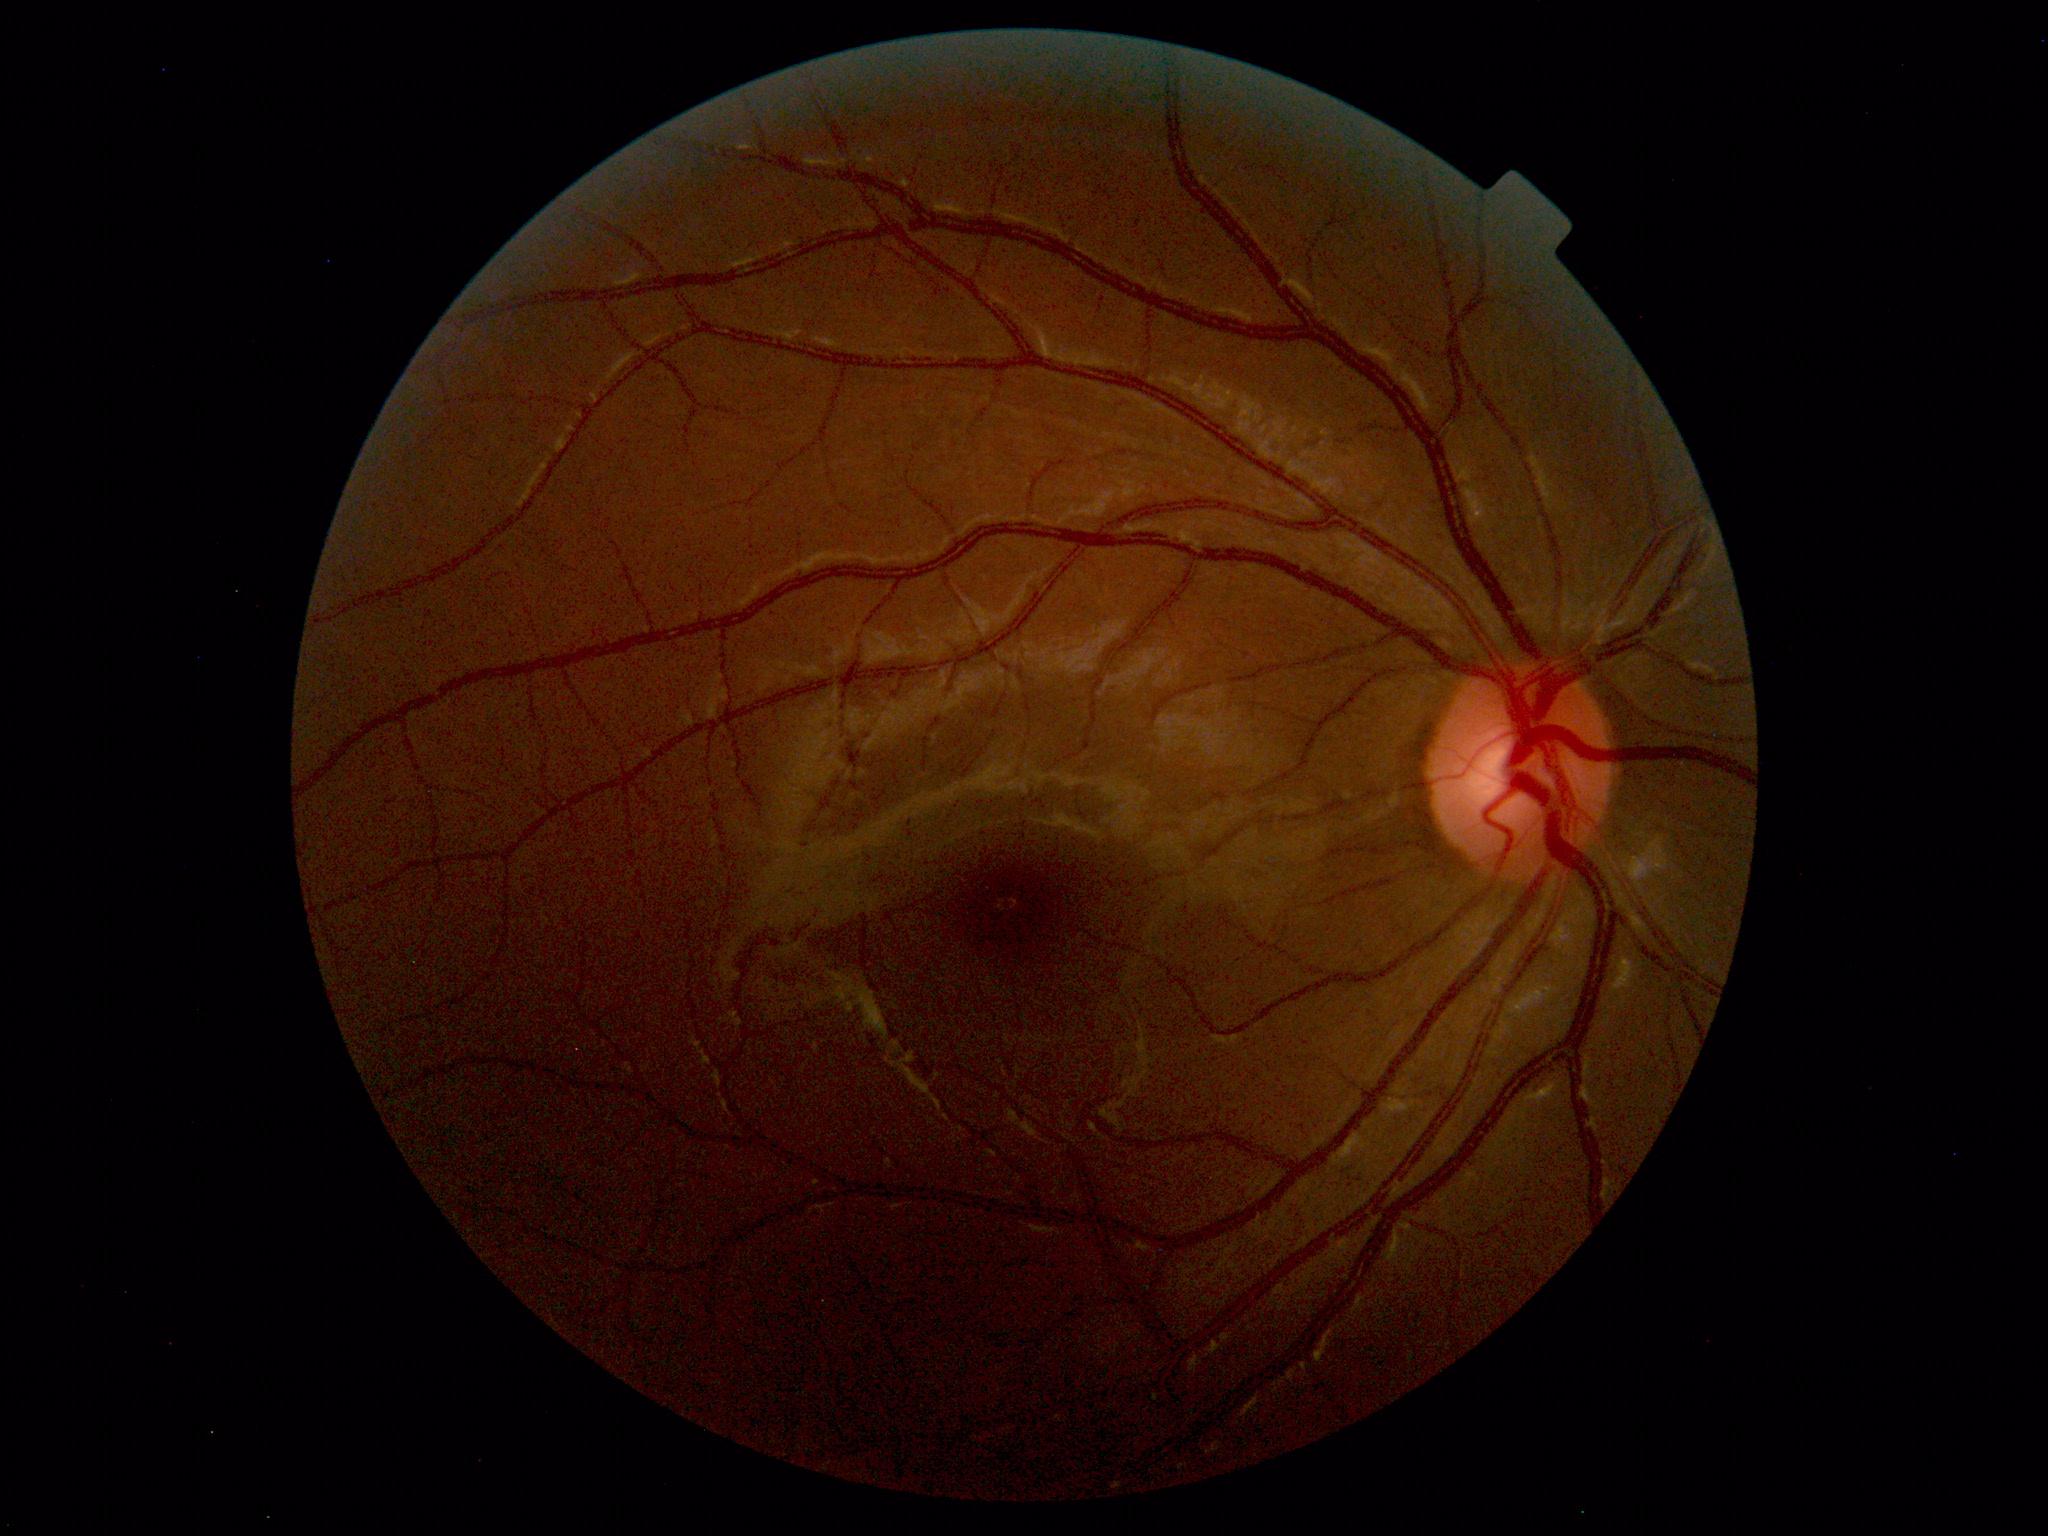 Findings: none. Normal fundus.